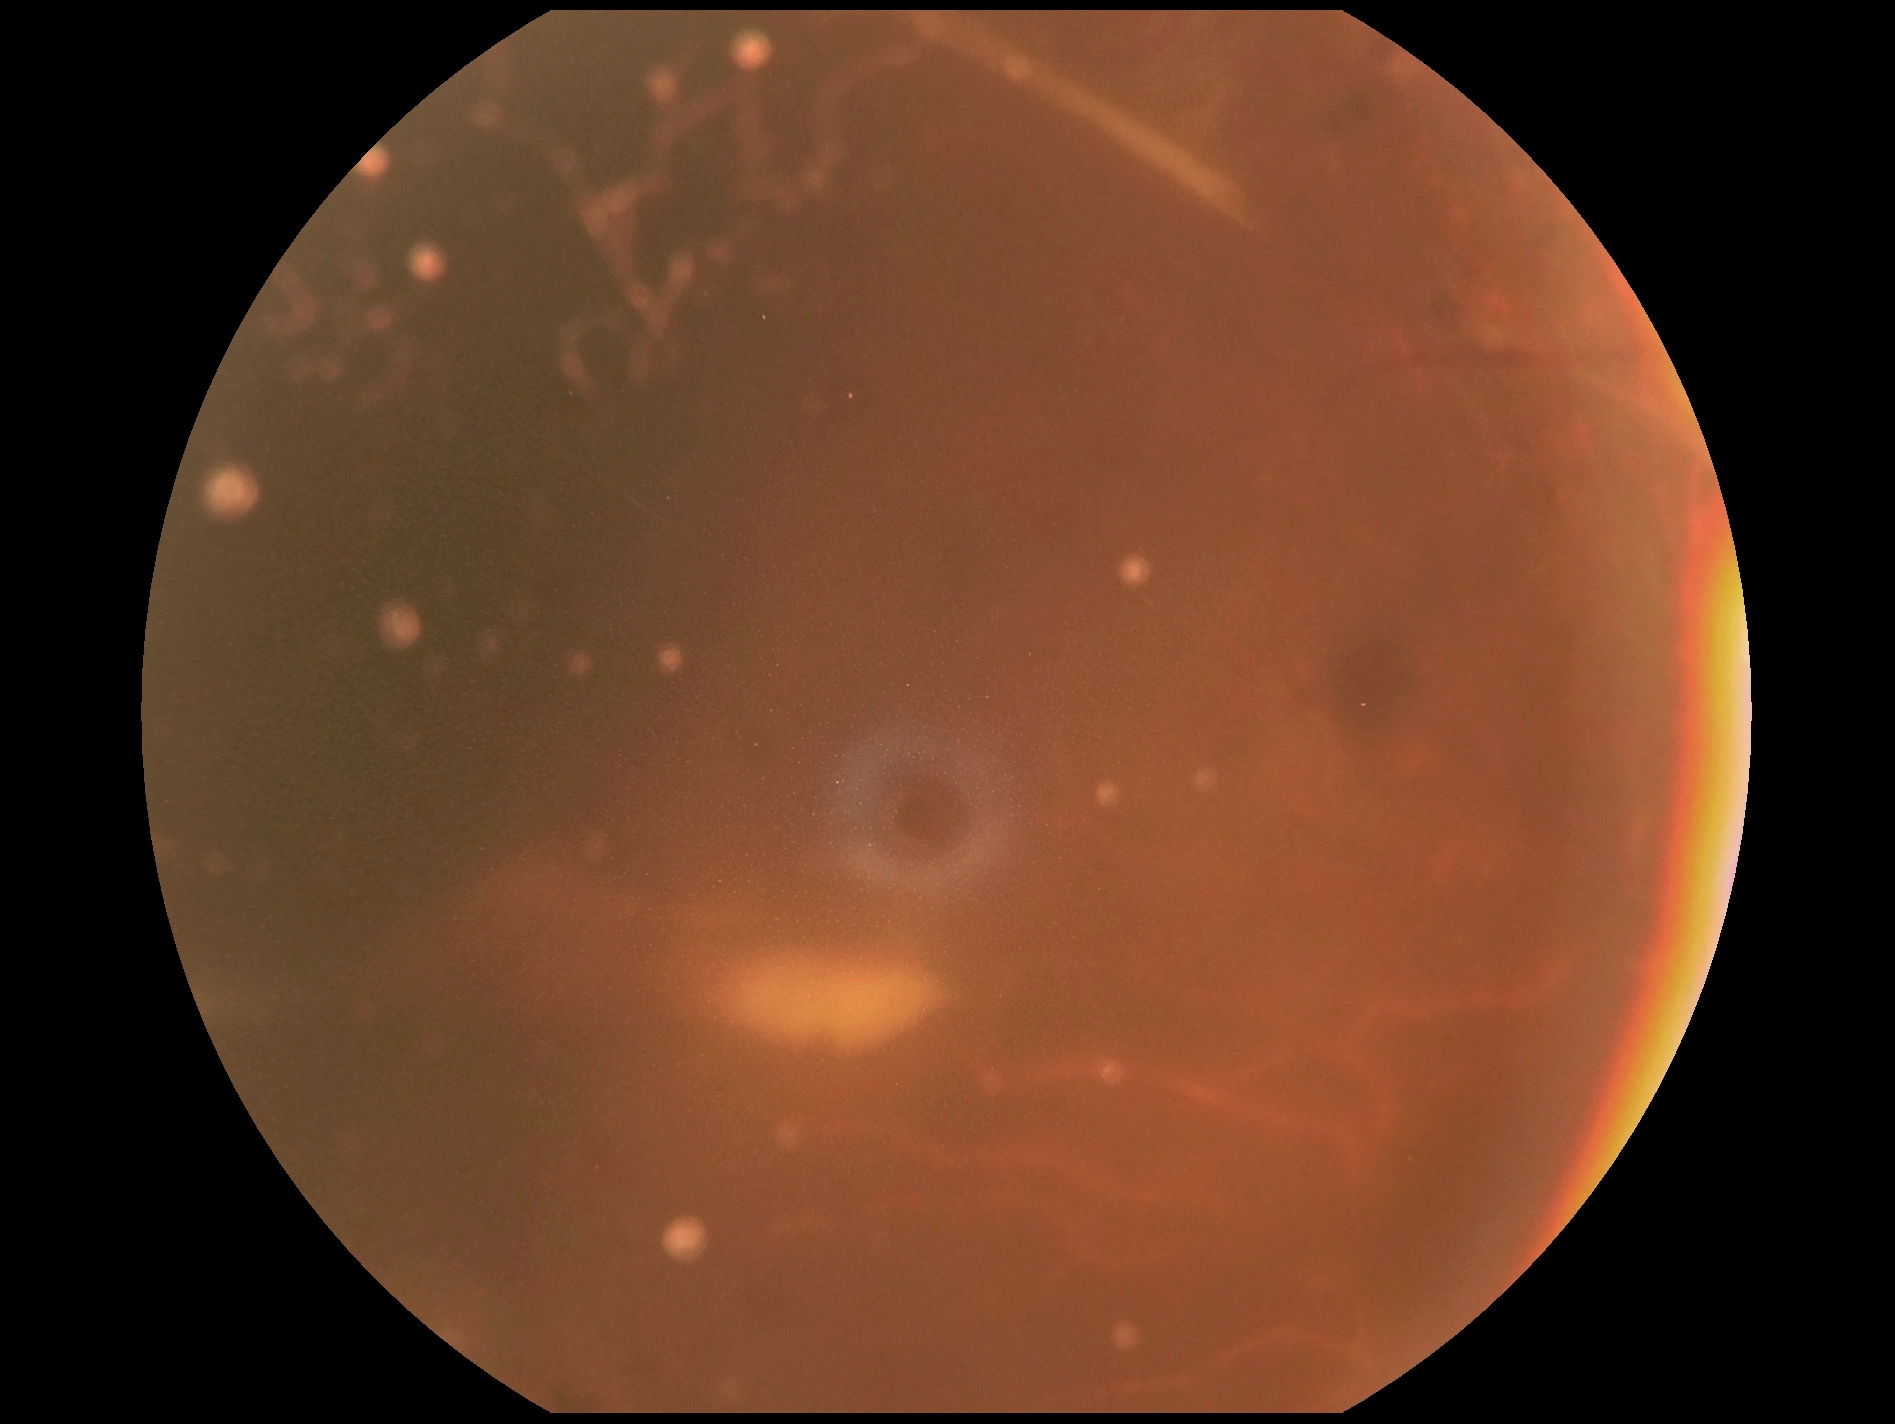
  dr_grade: ungradable